Image size 2346x1568 · color fundus image — 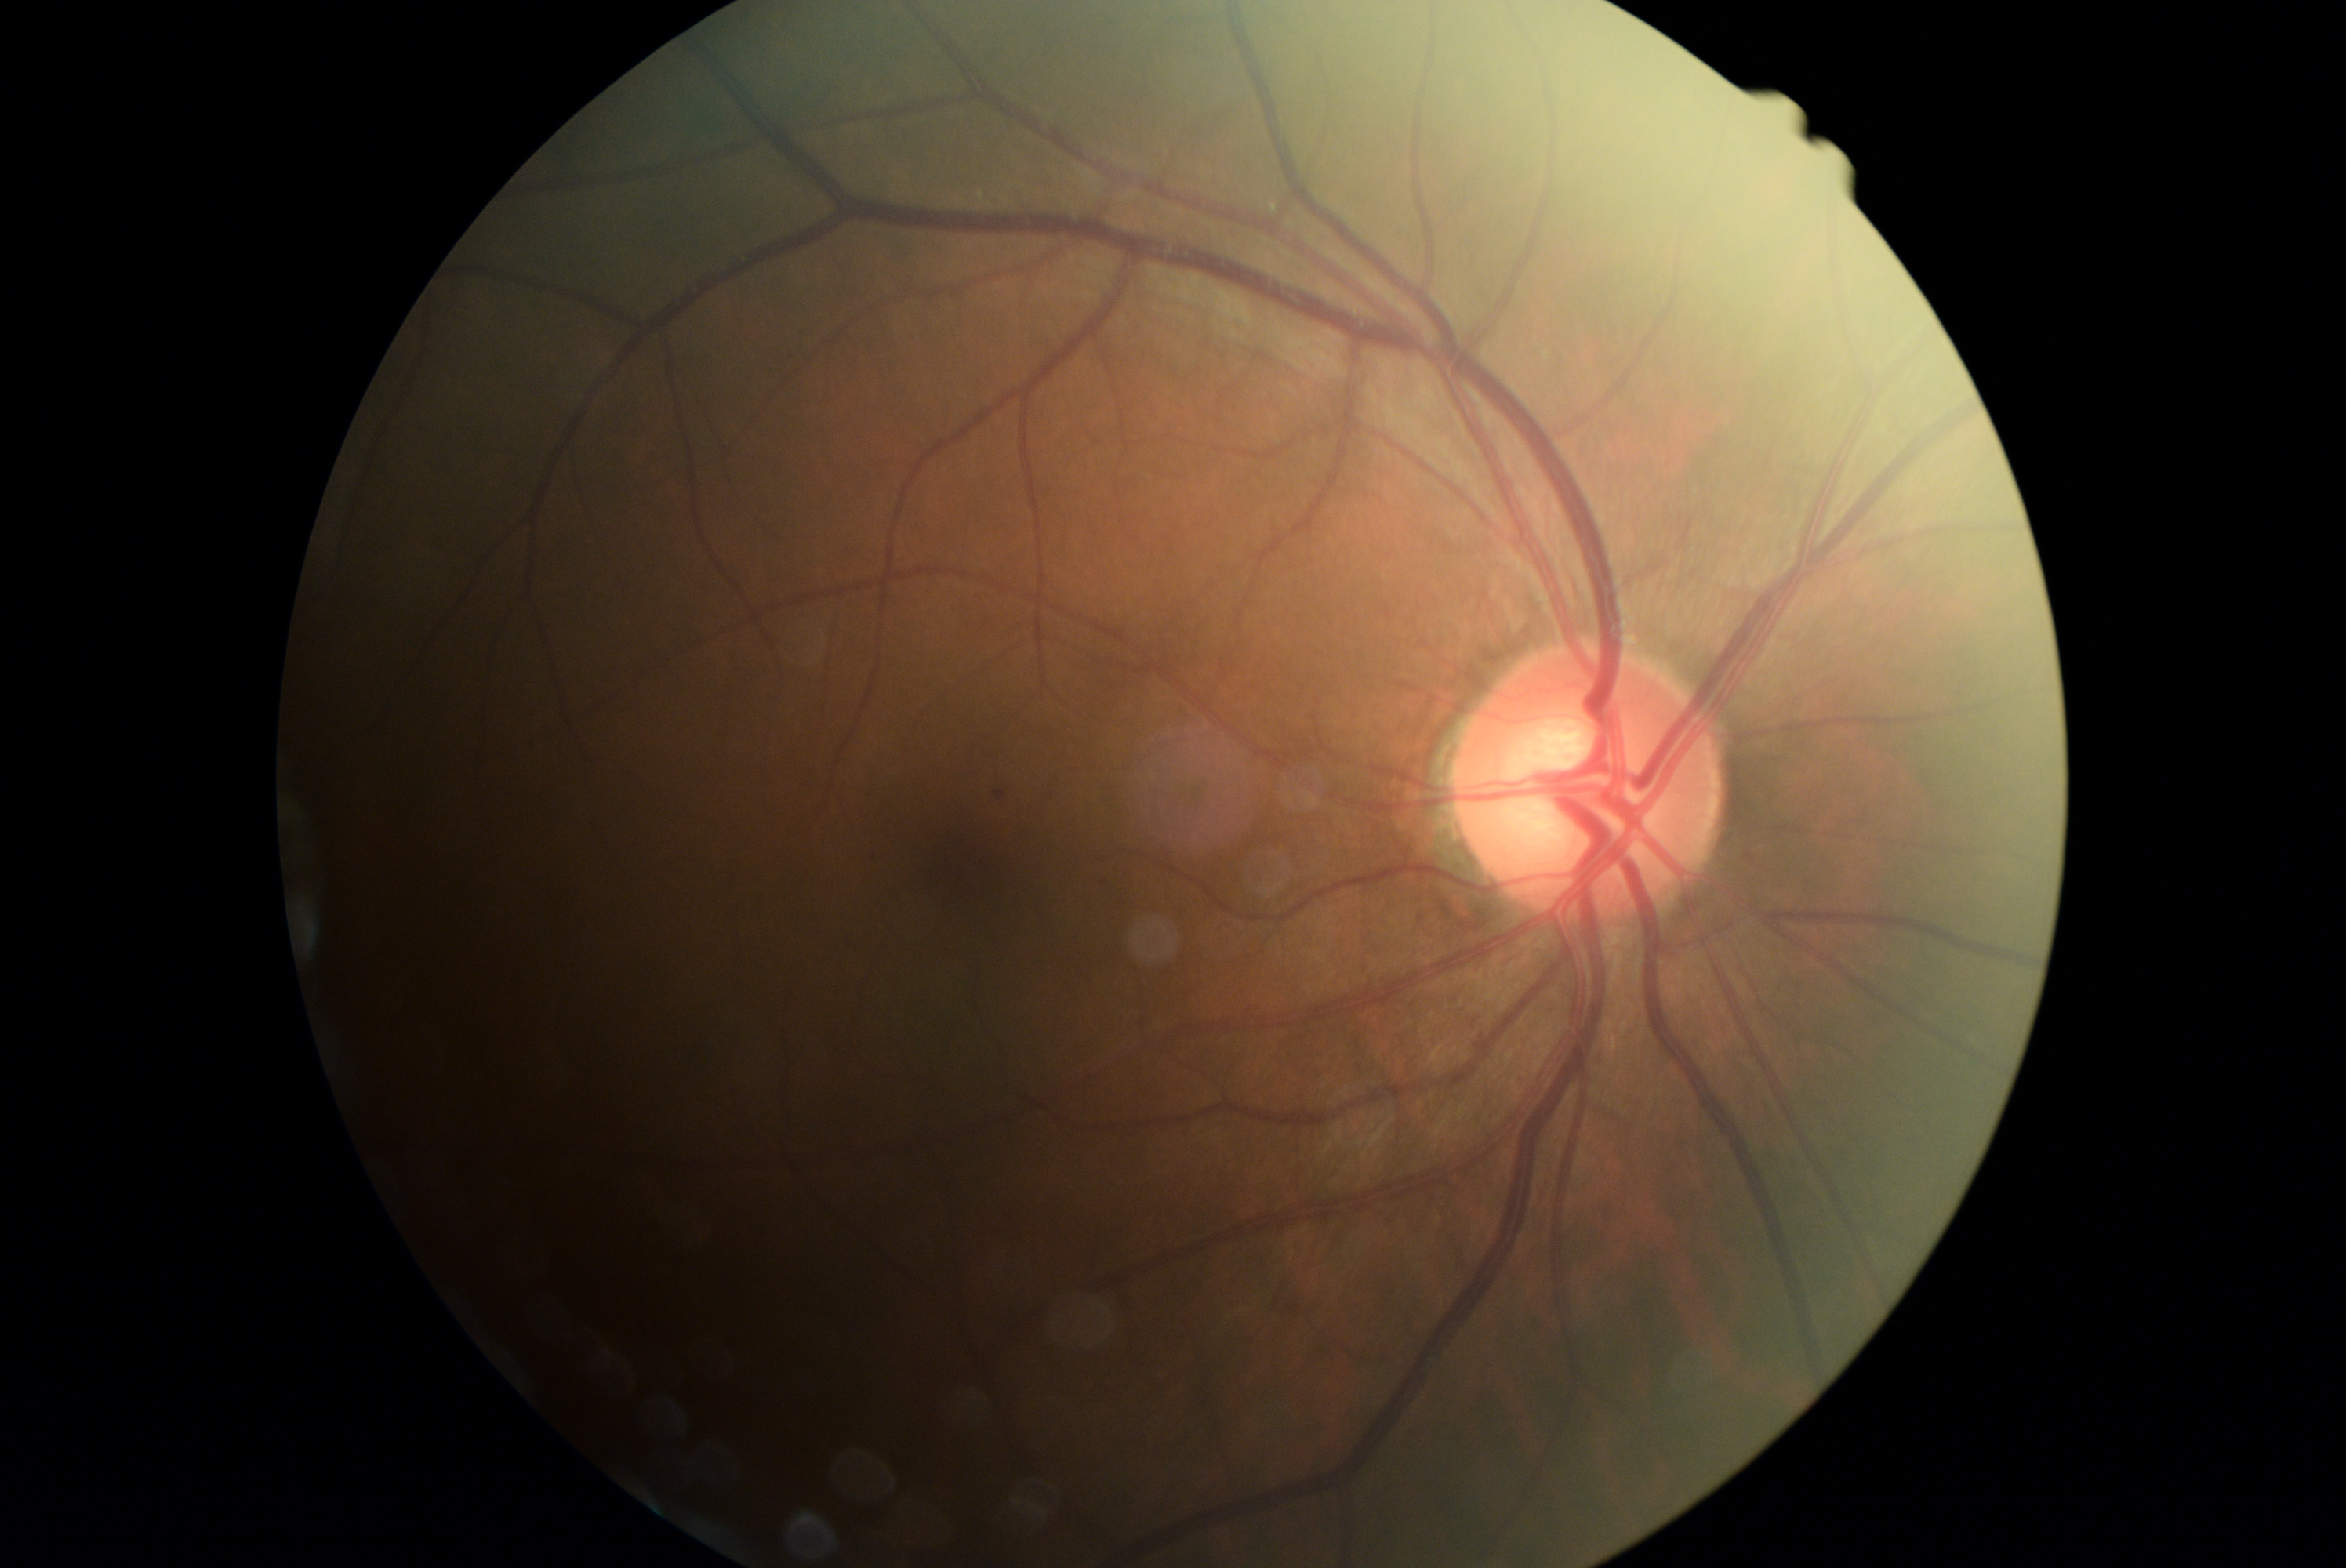
DR: grade 1.